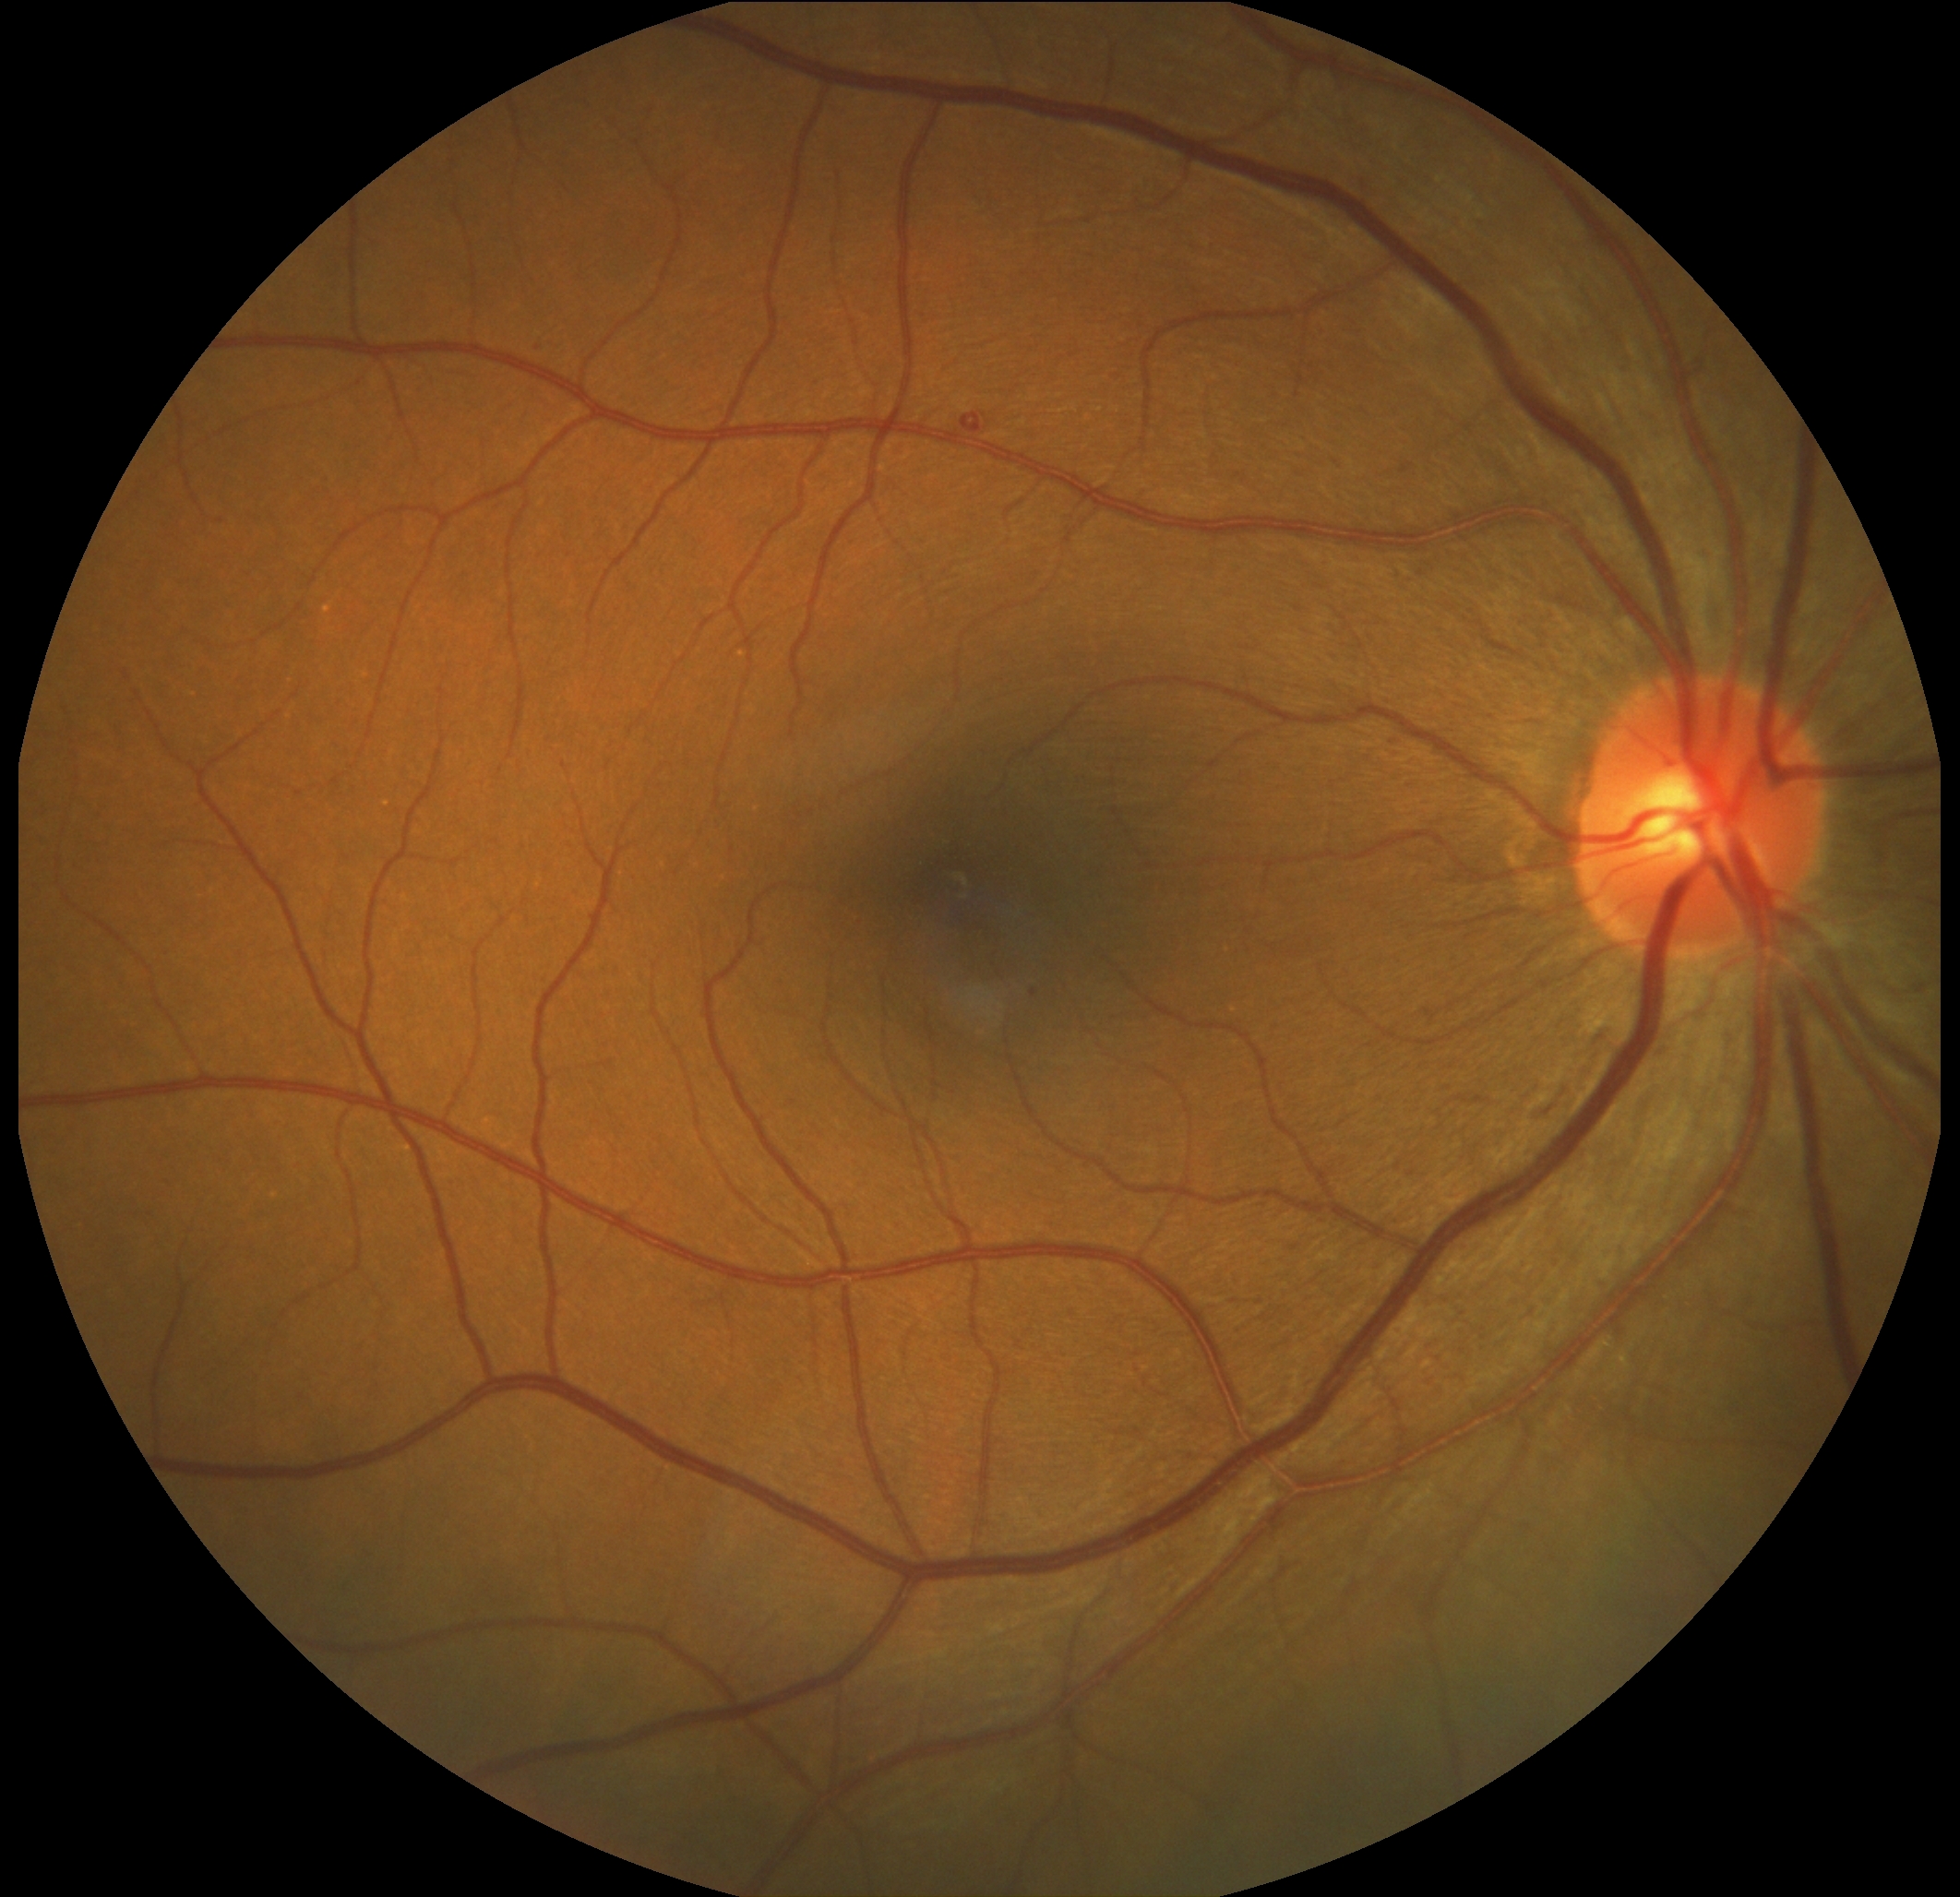
DR class: non-proliferative diabetic retinopathy. Retinopathy: 2.